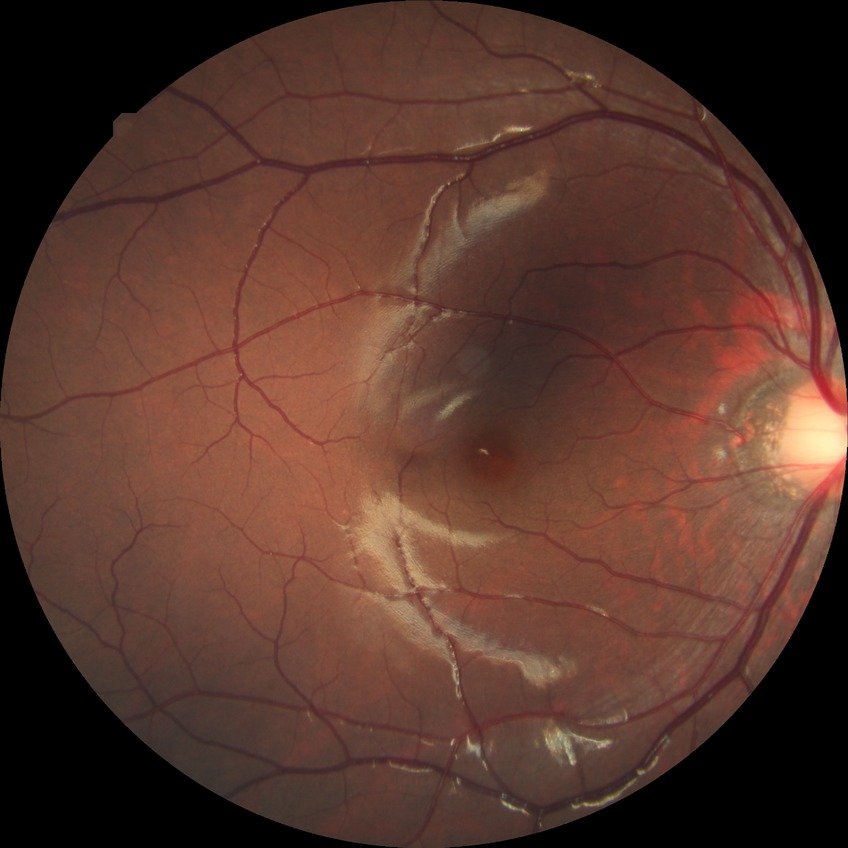 diabetic retinopathy grade=no diabetic retinopathy.